Wide-field fundus image from infant ROP screening:
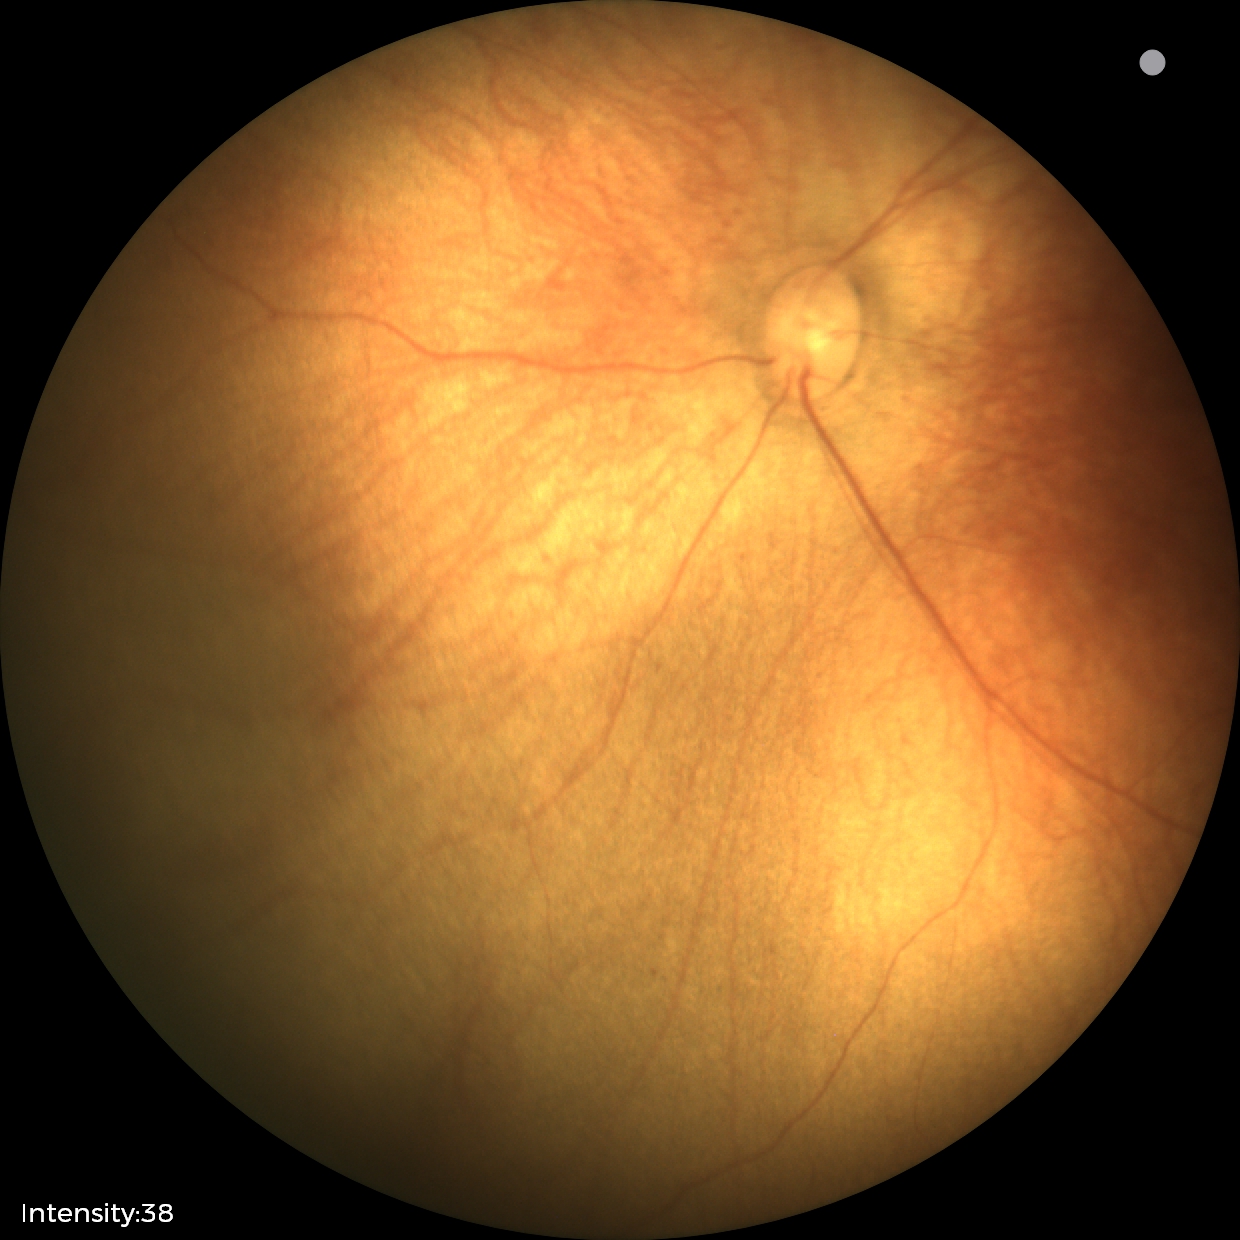
Screening examination diagnosed as physiological.